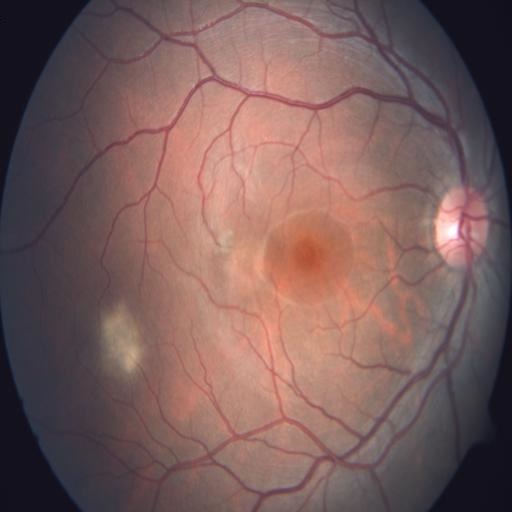

Showing central serous retinopathy.